Color fundus image — 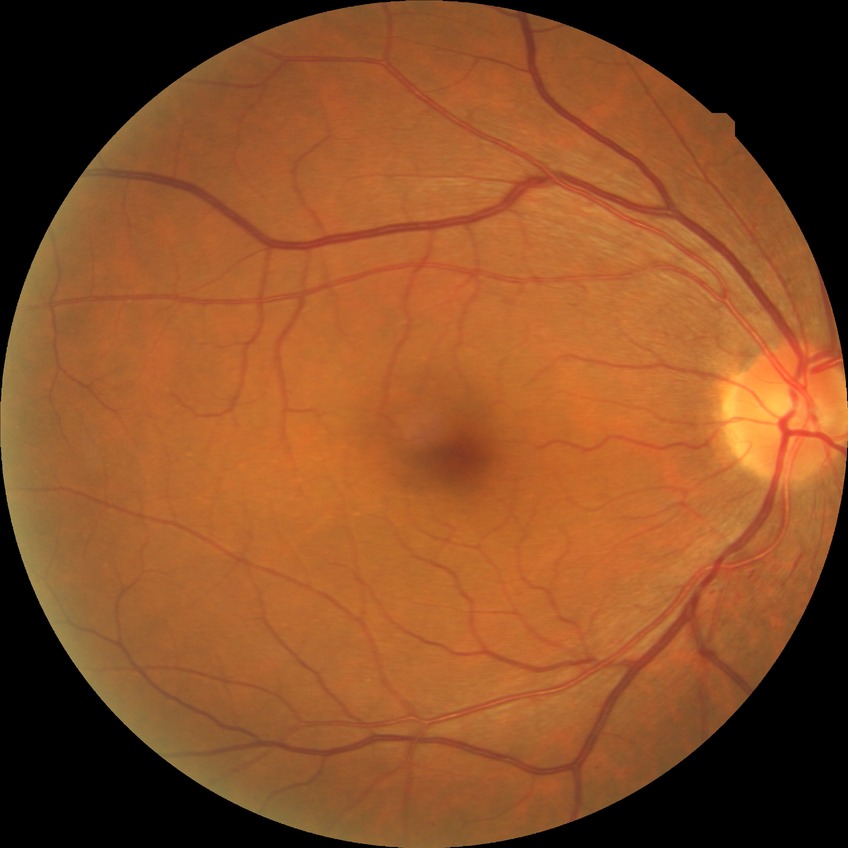

Diabetic retinopathy (DR): no diabetic retinopathy (NDR).